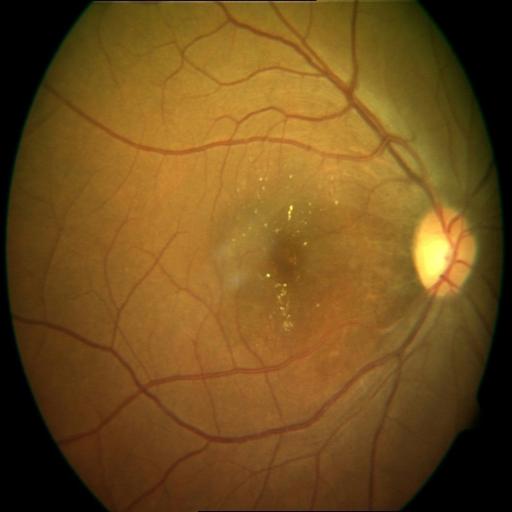
Abnormalities (2): epiretinal membrane | cystoid macular edema.